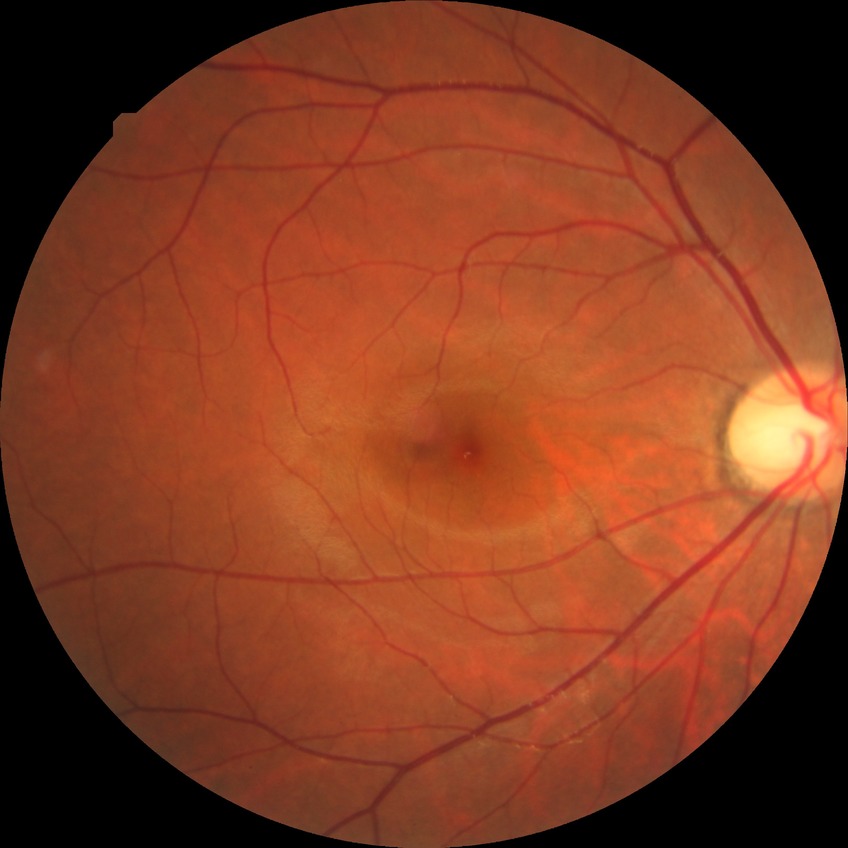
No DR findings. DR severity is NDR.